1960x1897, 45° FOV.
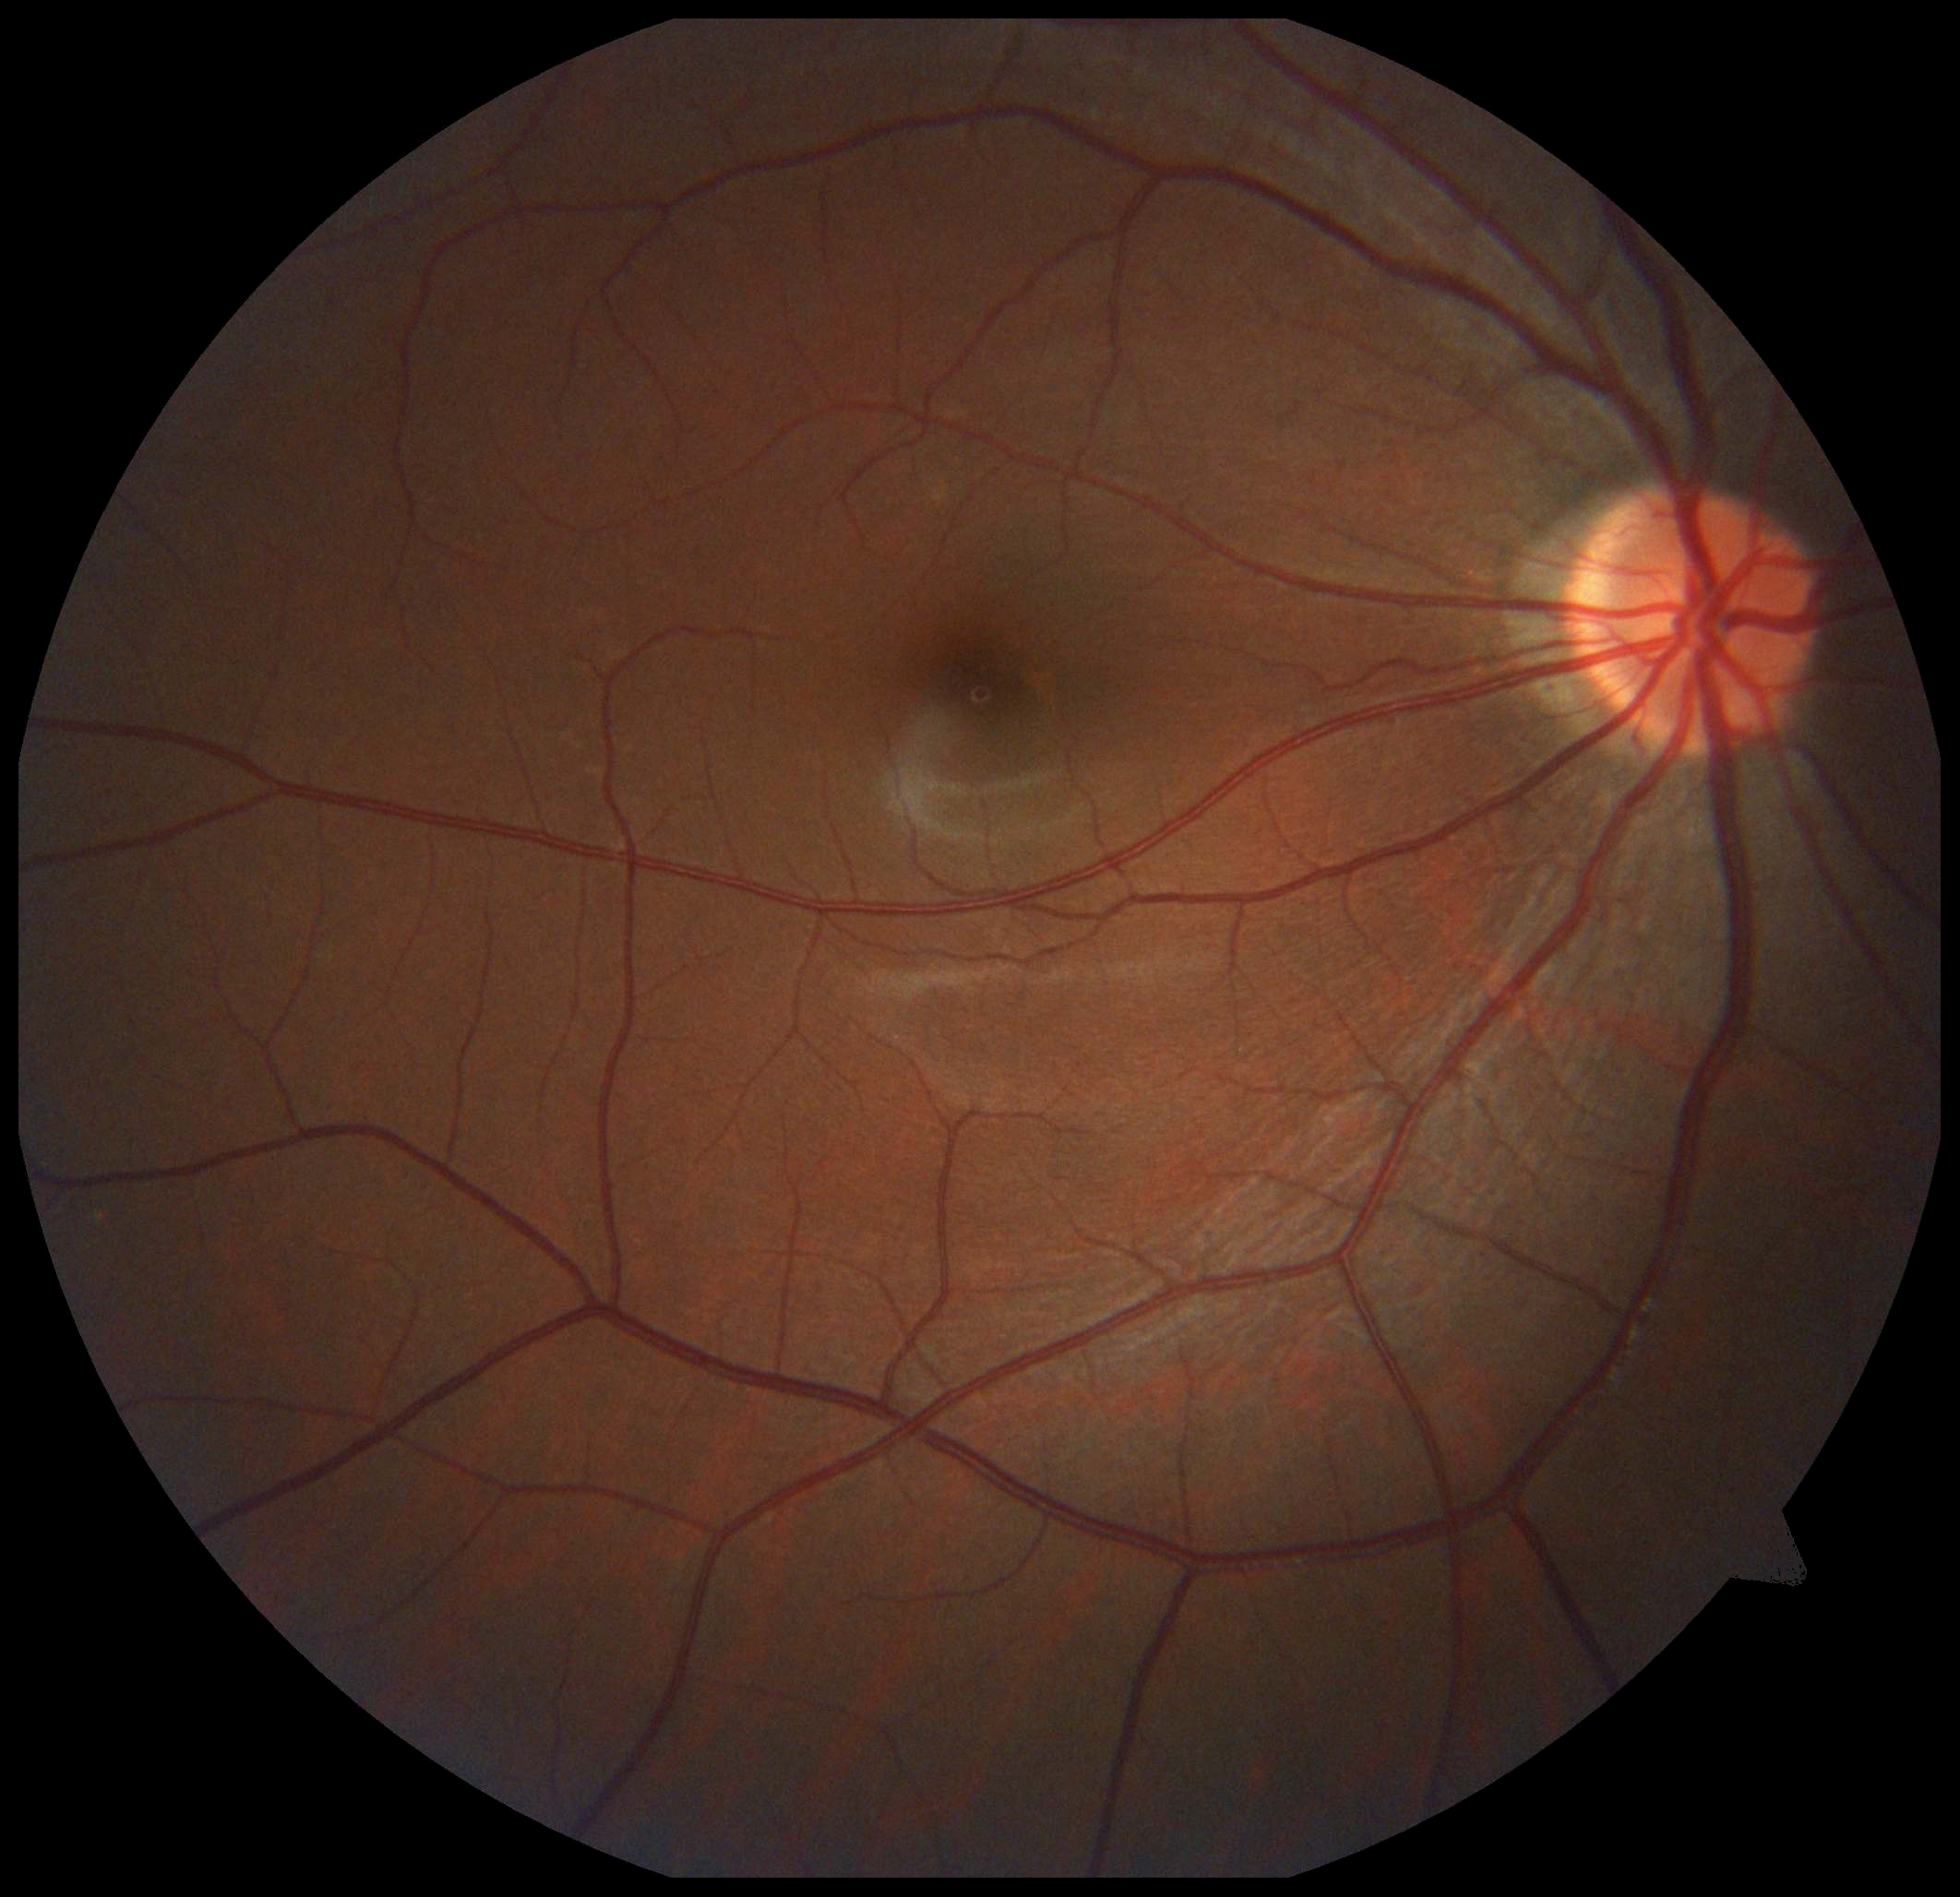

Diabetic retinopathy grade is 0 (no apparent retinopathy).